Portable fundus photograph:
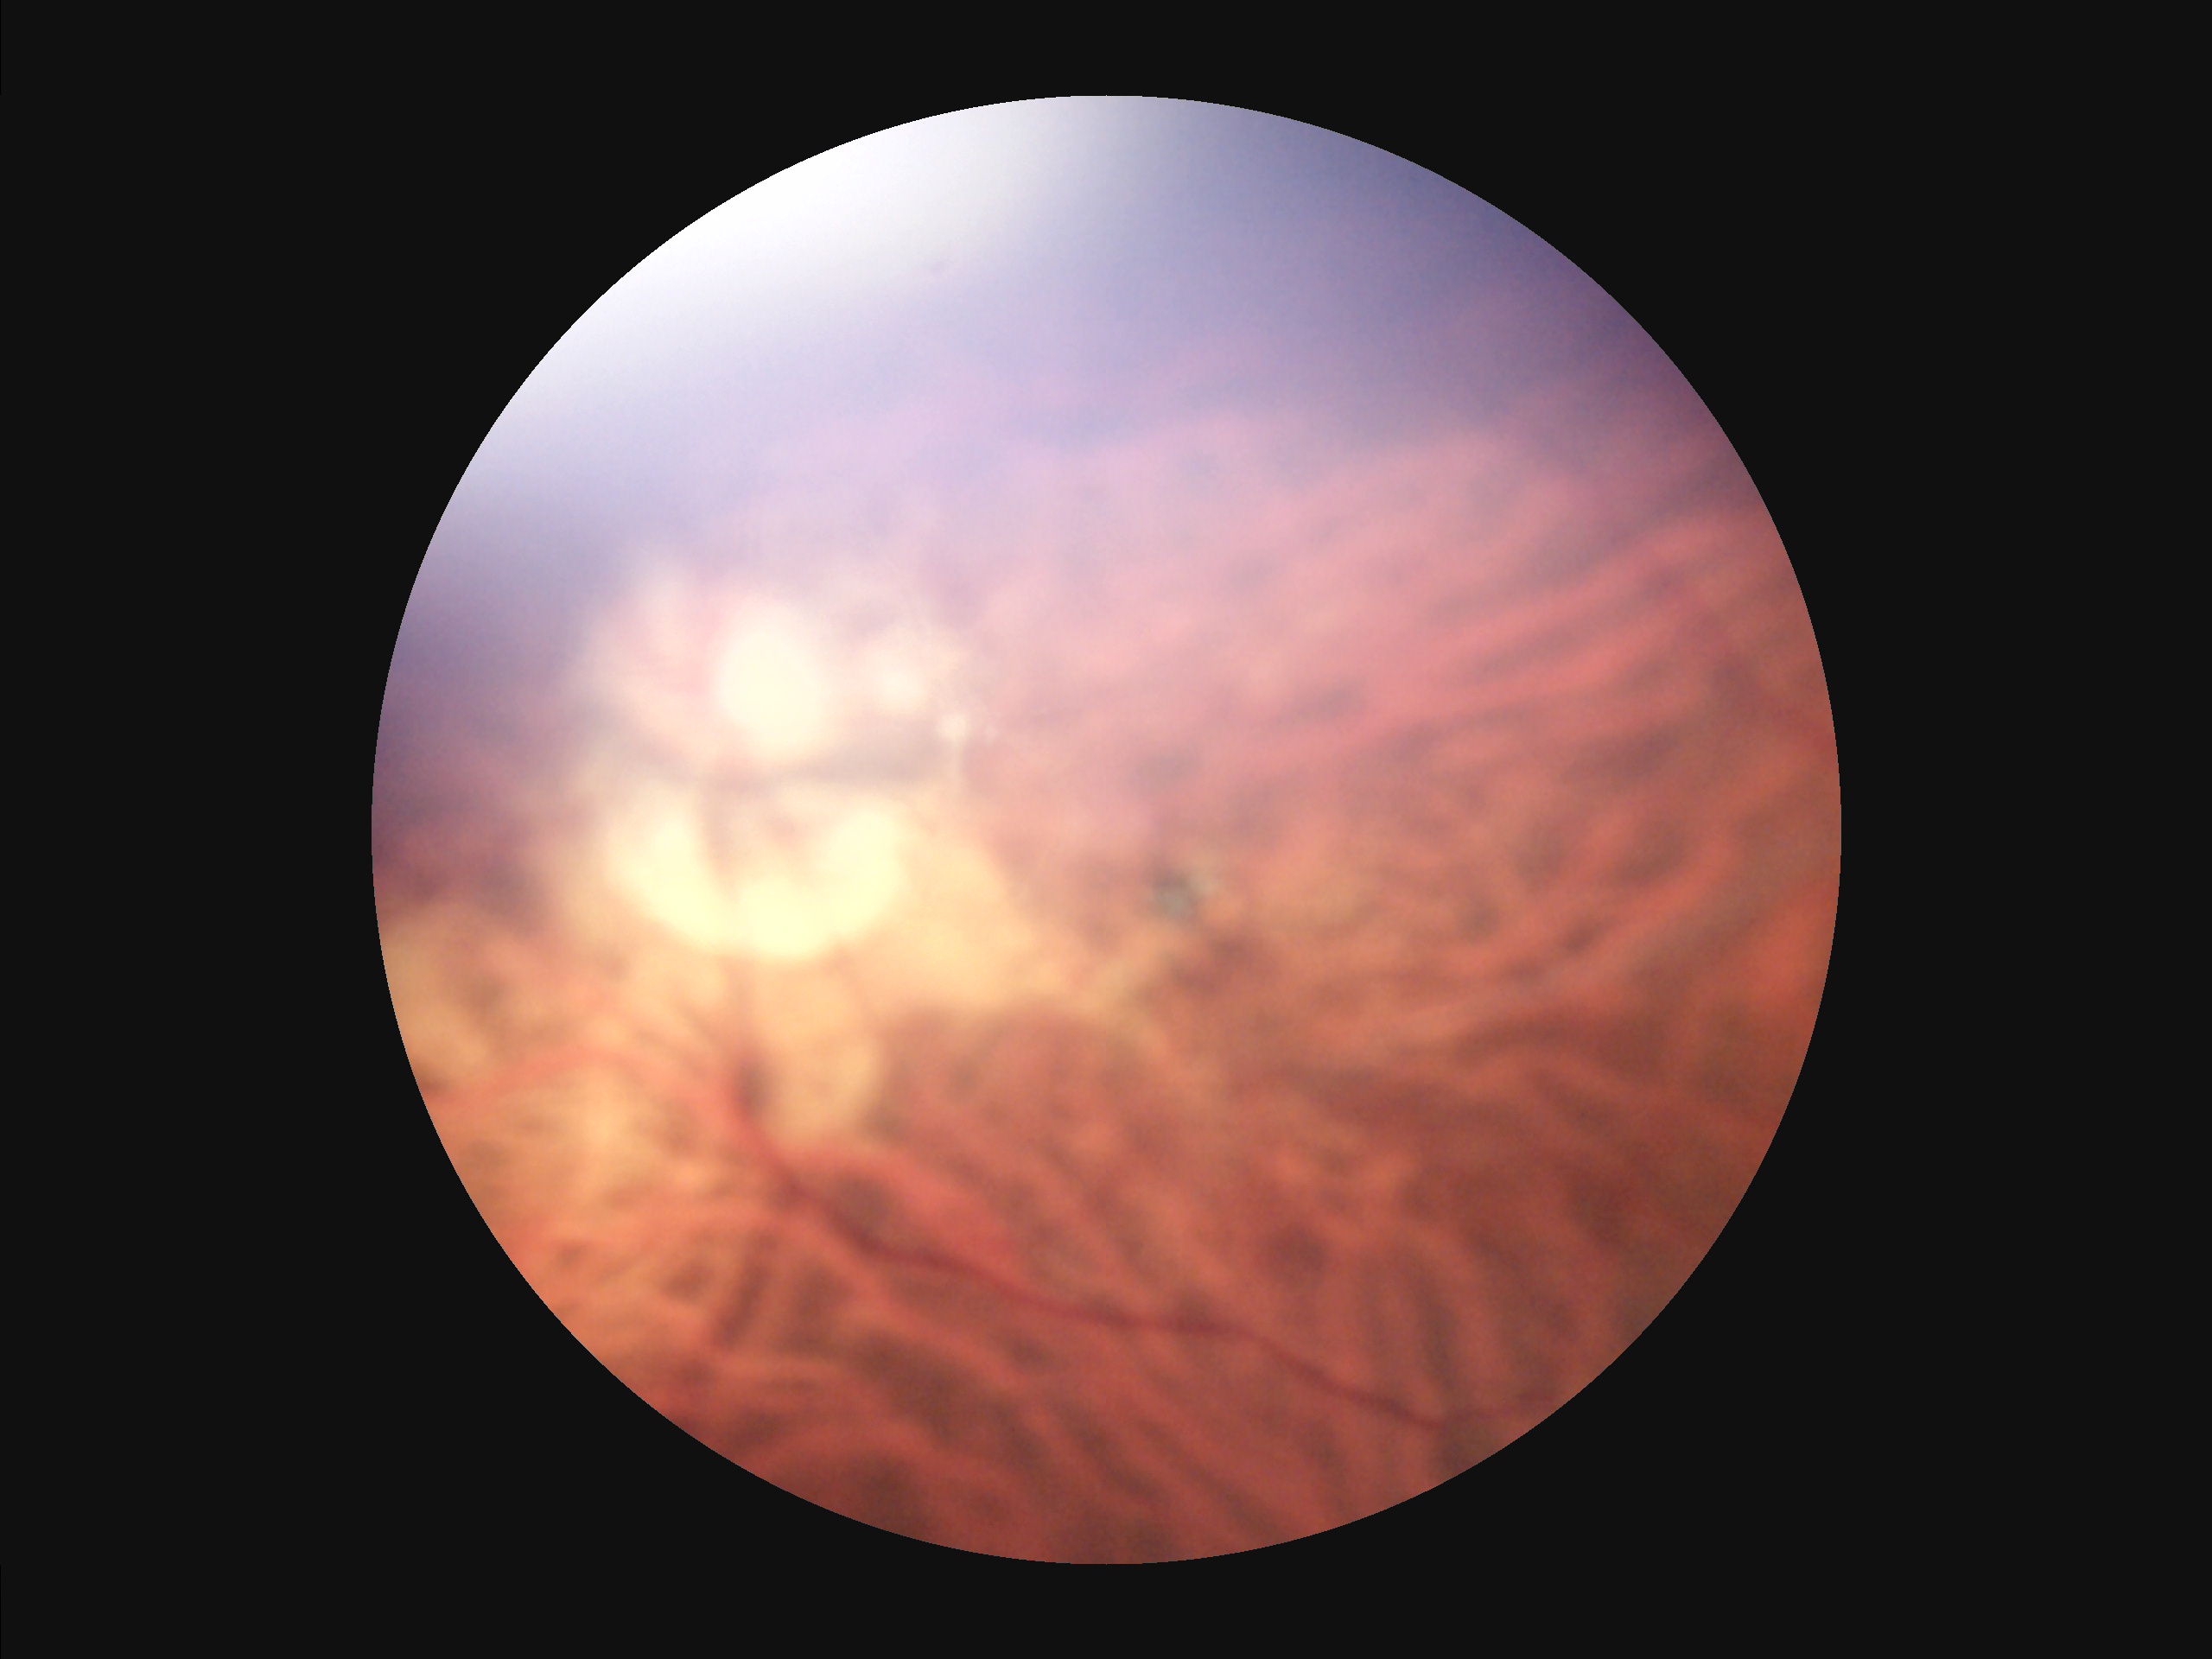 Overall image quality is poor.
Narrow intensity range; structures are hard to distinguish.
Noticeable blur in the optic disc, vessels, or background.
Illumination is uneven.